848x848px · without pupil dilation: 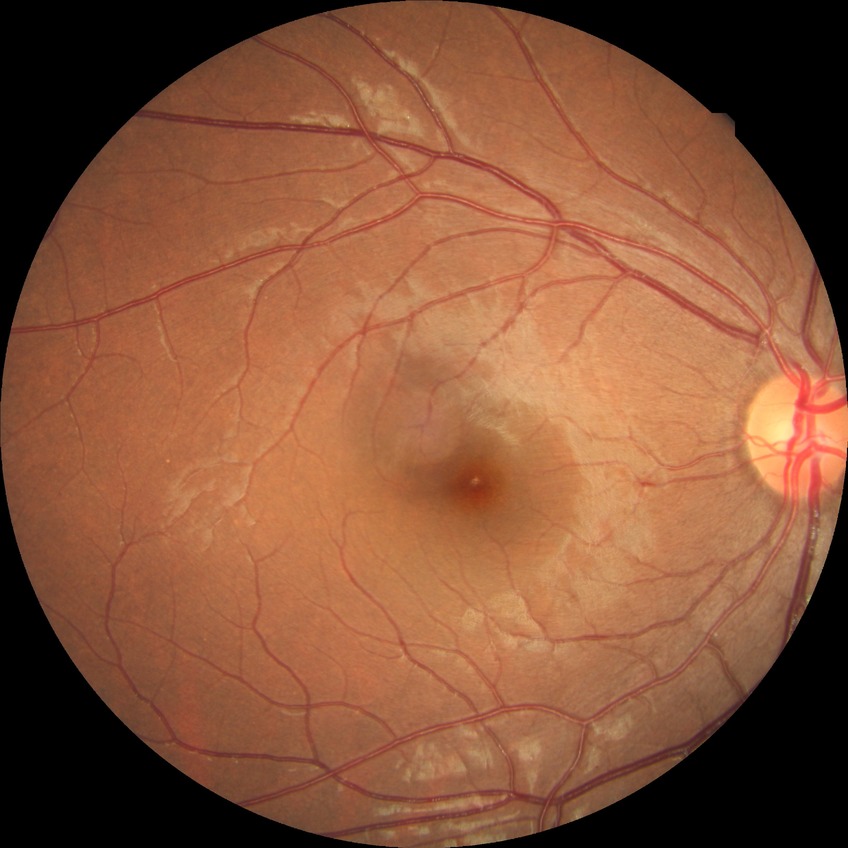

davis_grade: no diabetic retinopathy (NDR)